45-degree field of view: 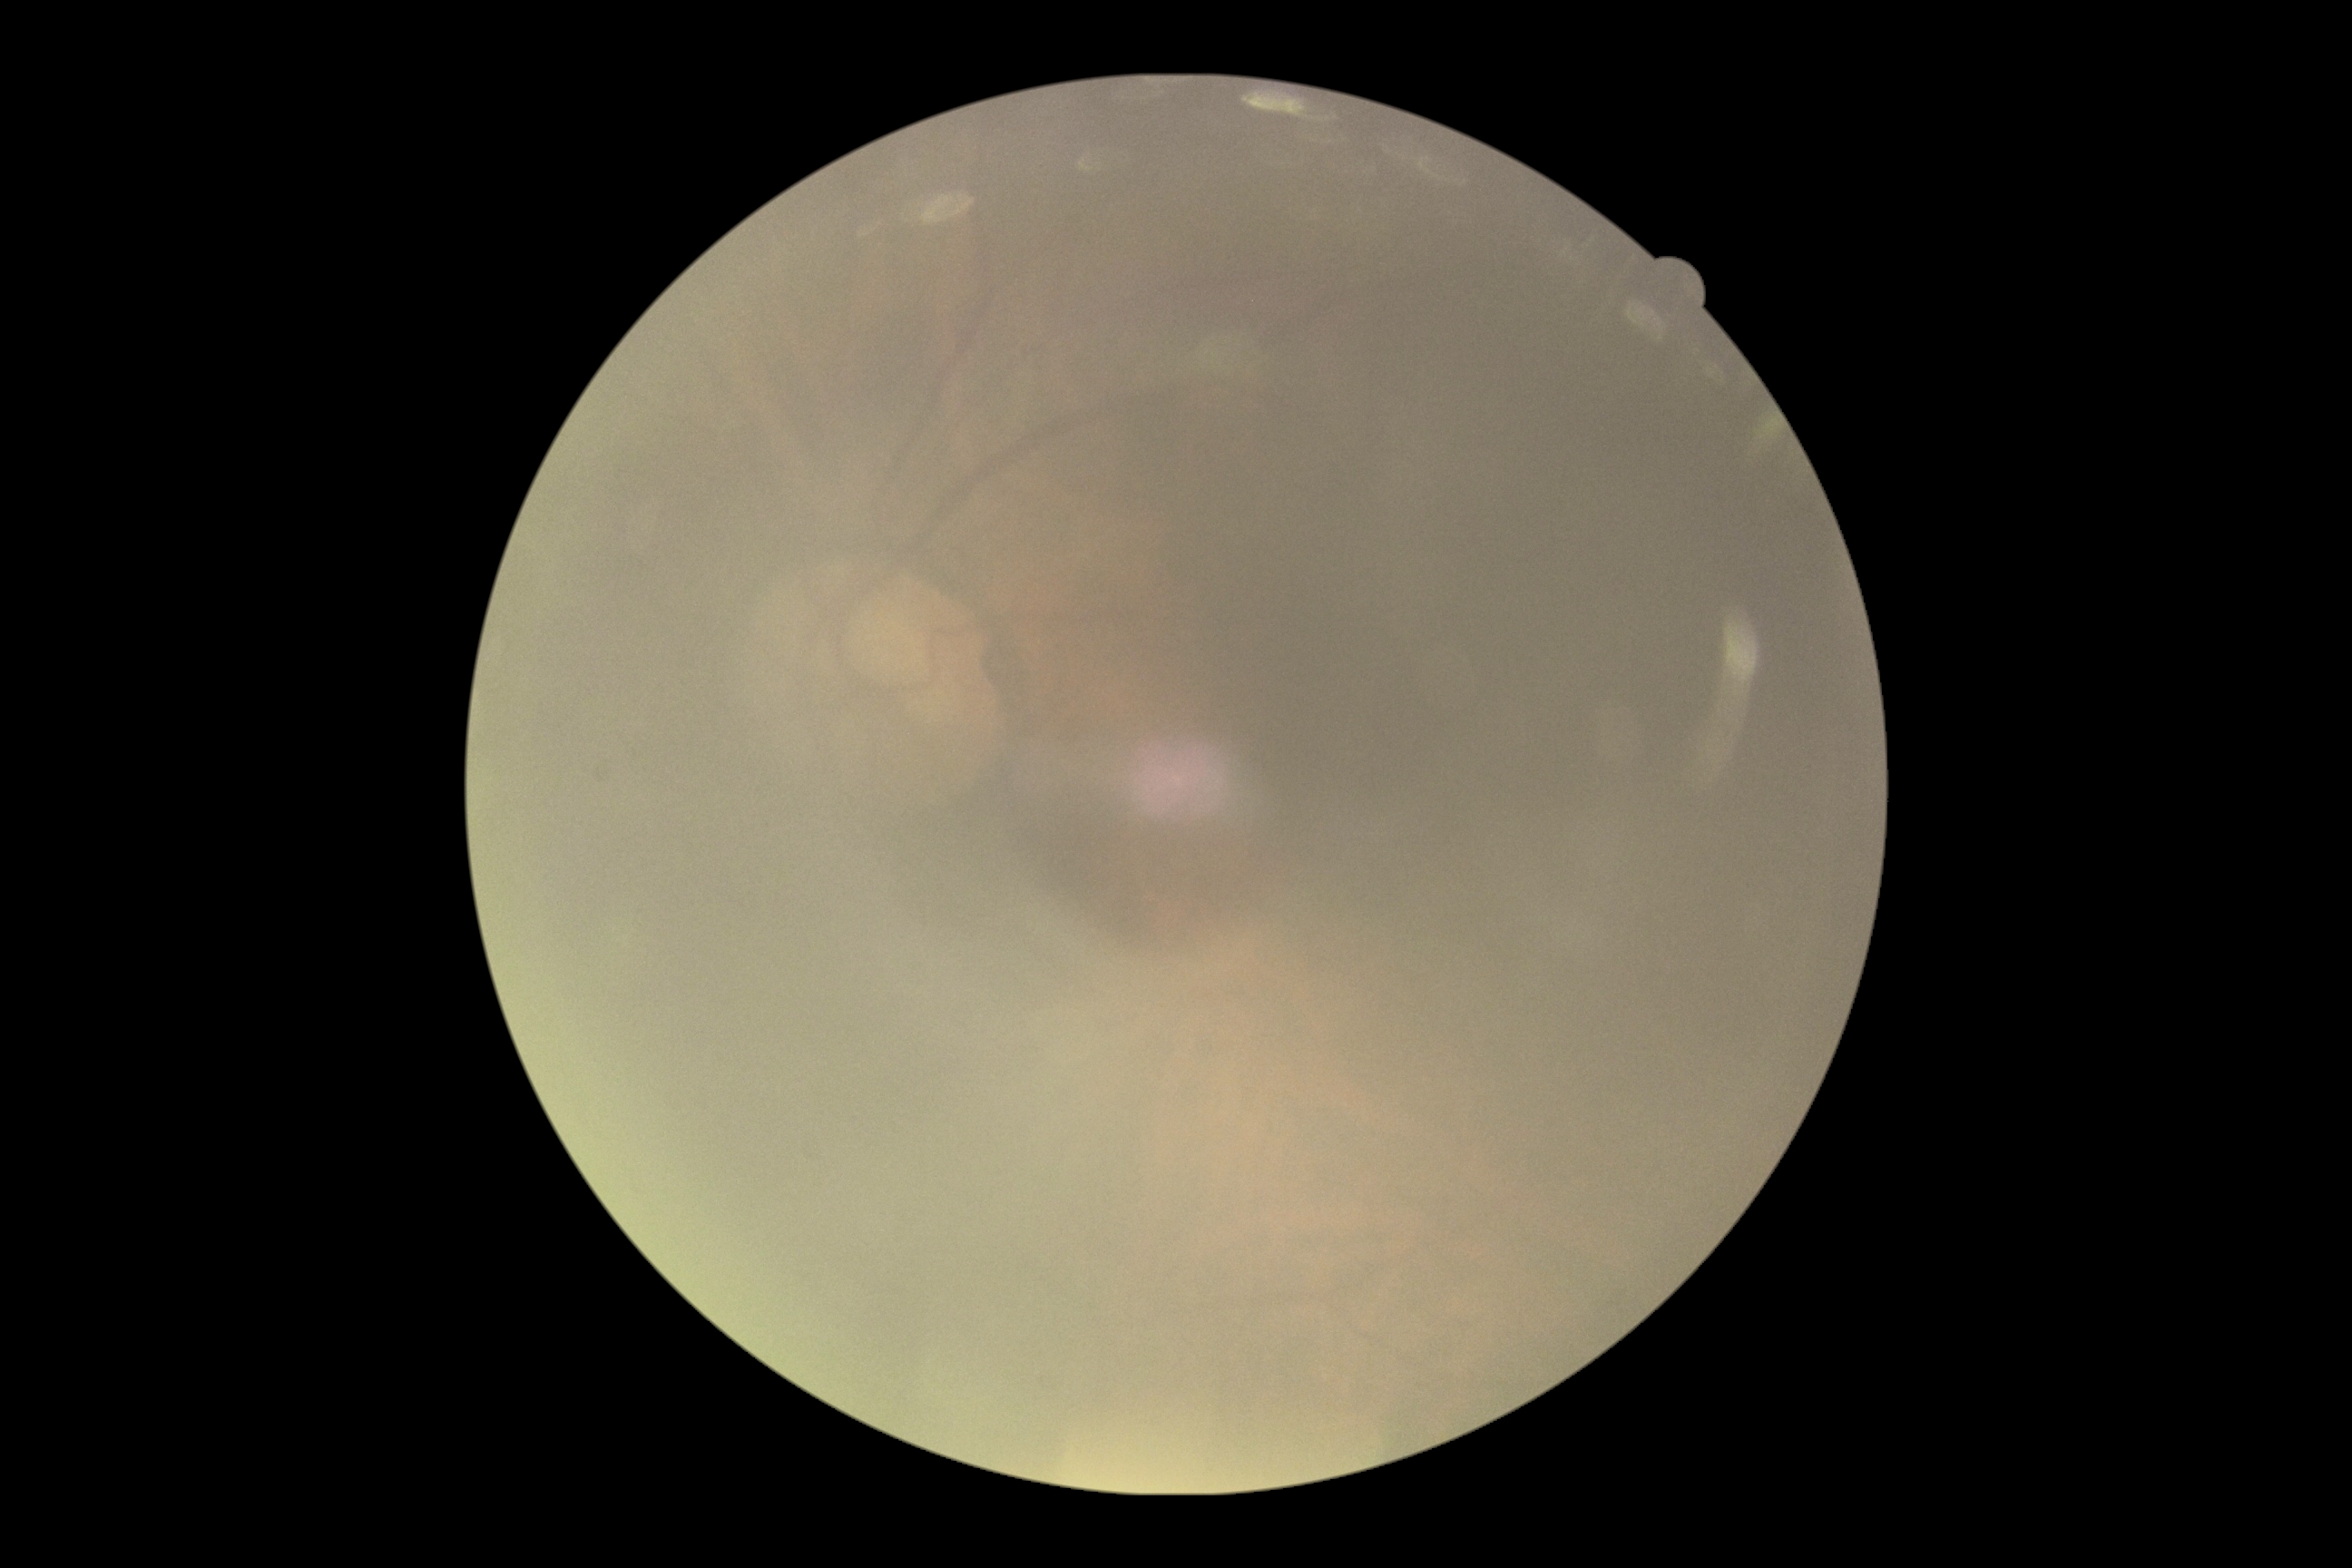 Diabetic retinopathy (DR): ungradable.